45-degree field of view, 2352x1568px — 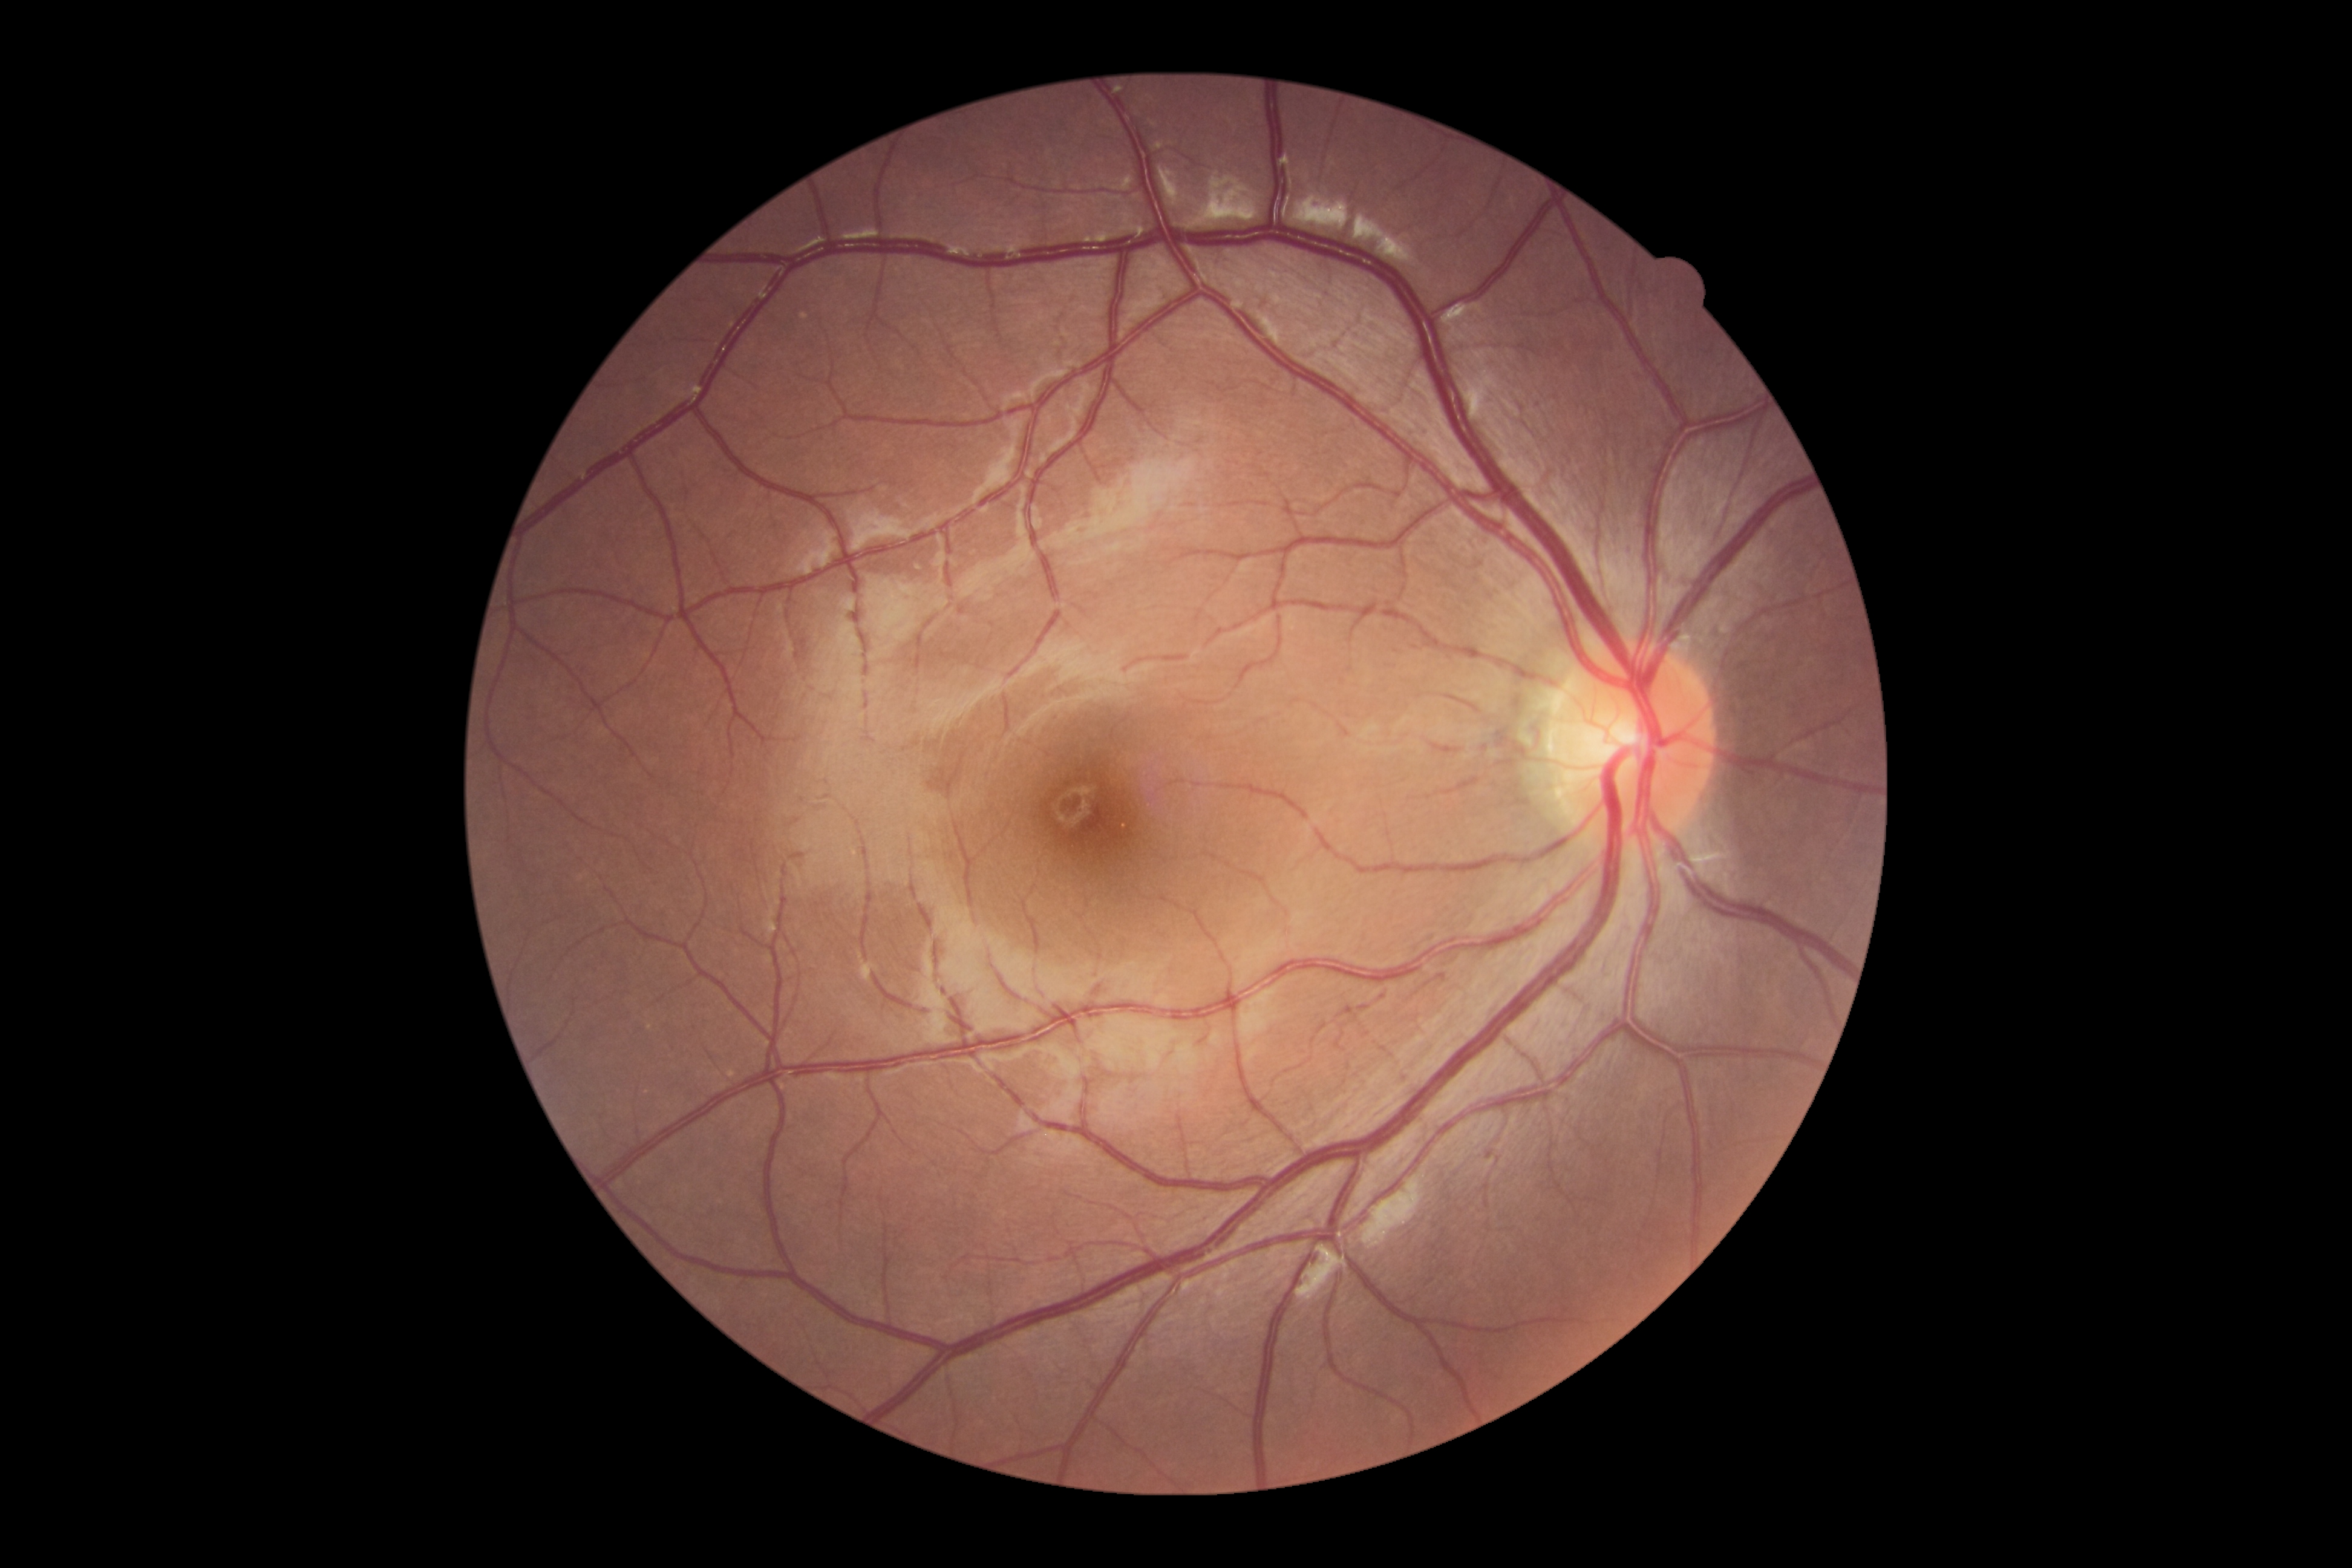 No DR findings.
Diabetic retinopathy (DR): 0.